Fundus photo: 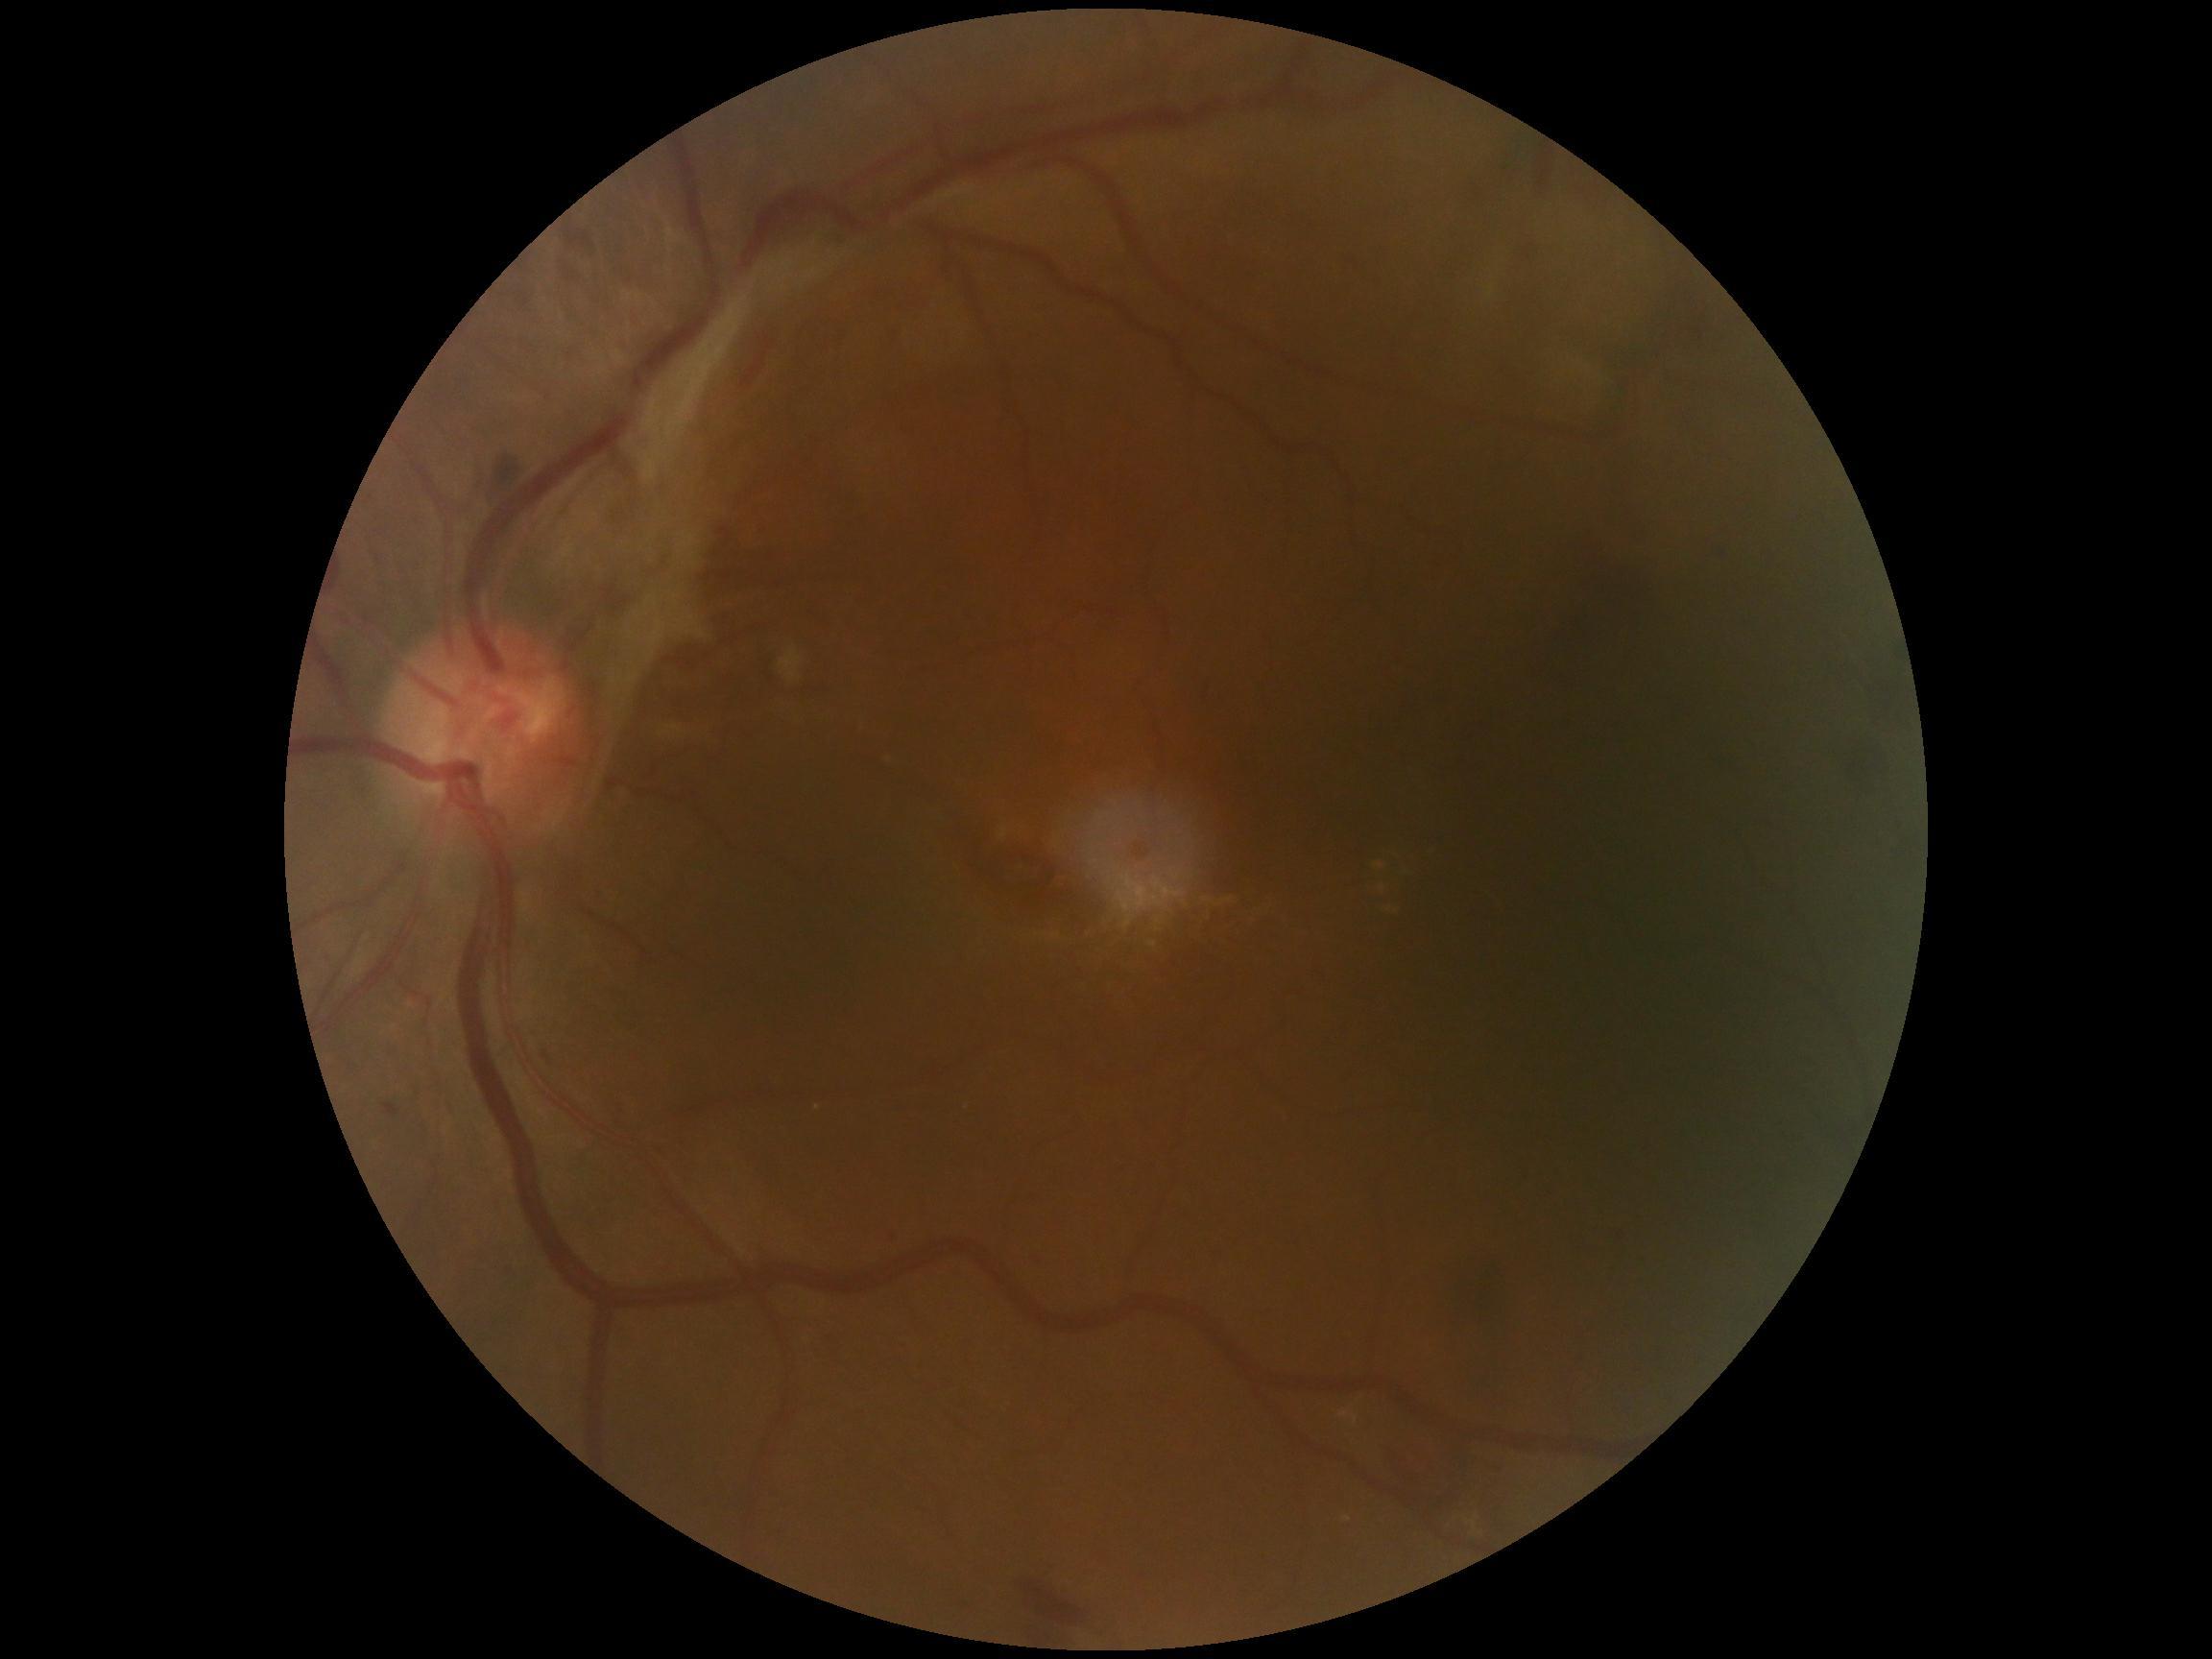

Diabetic retinopathy grade is proliferative diabetic retinopathy (4).